Acquired with a NIDEK AFC-230, image size 848x848, posterior pole color fundus photograph, 45 degree fundus photograph.
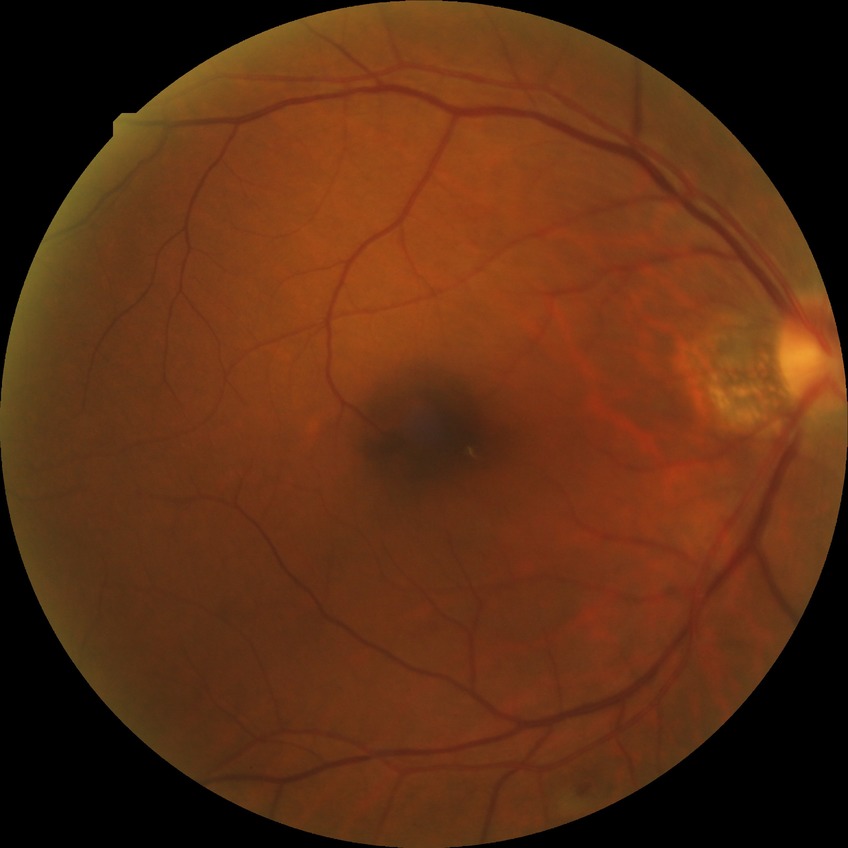
Diabetic retinopathy severity: no diabetic retinopathy.